FOV: 50 degrees; color fundus image; pupil-dilated.
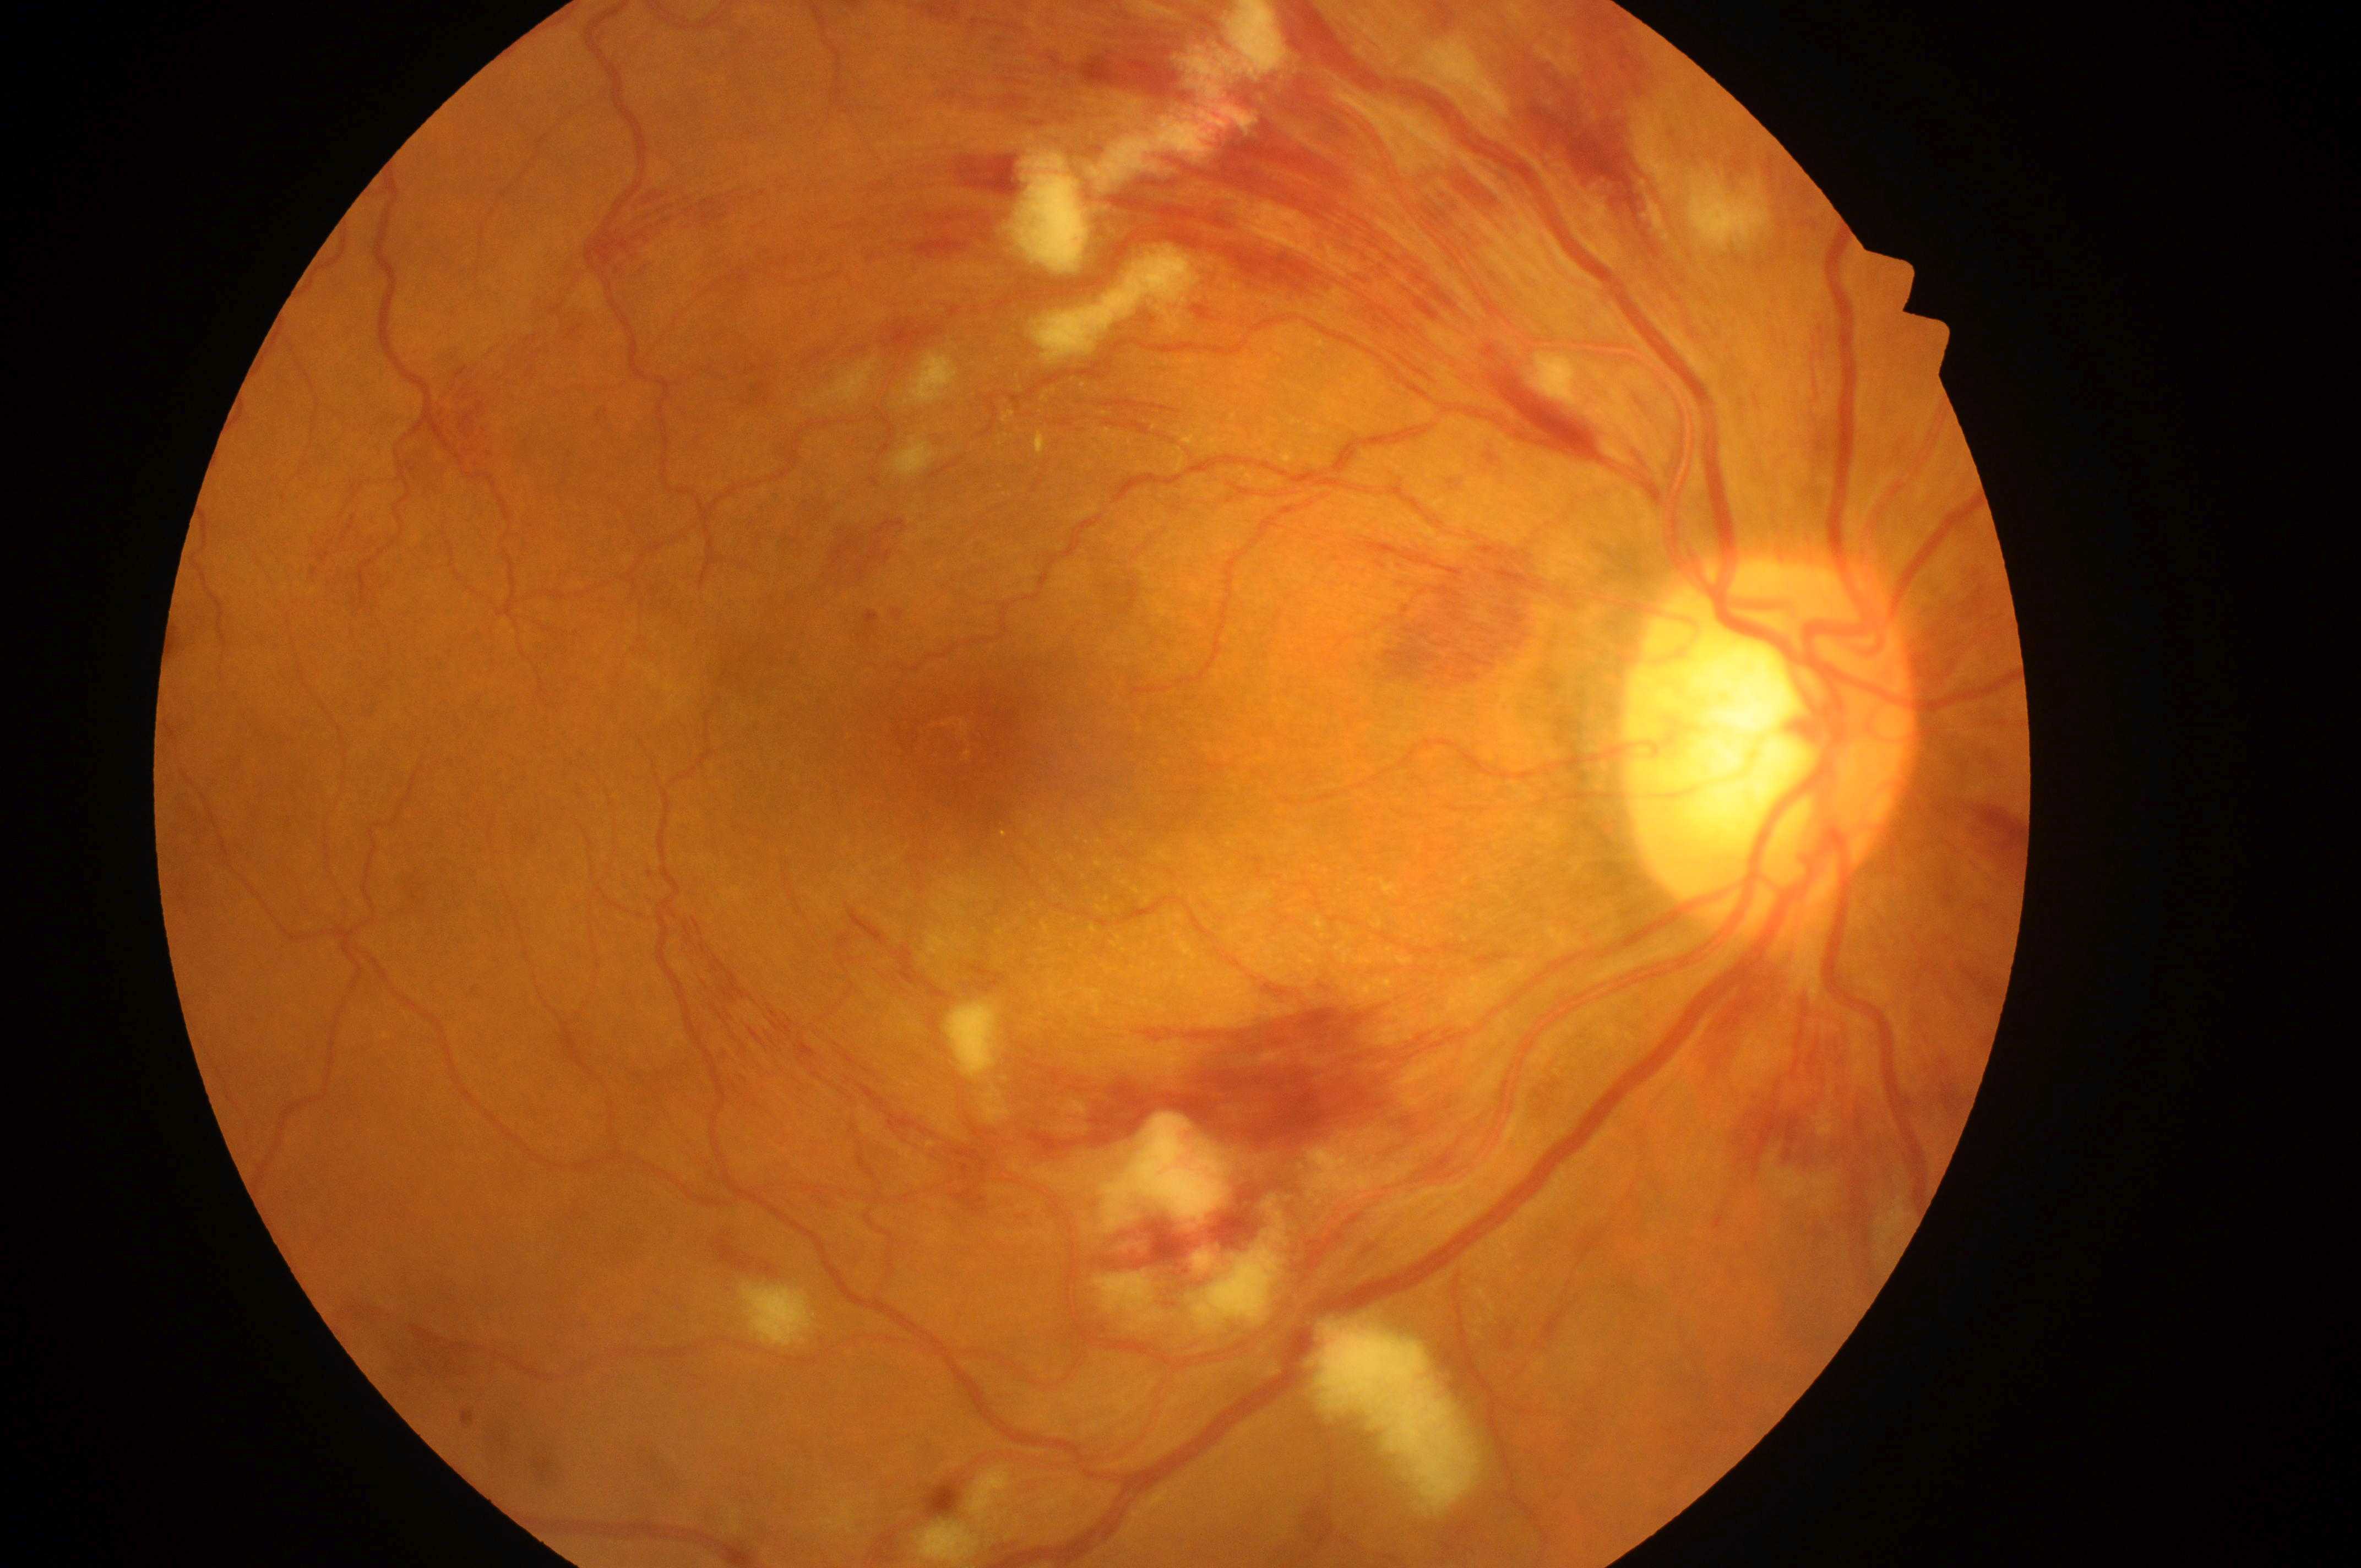

- macula center · (959,740)
- ONH · (1761,748)
- DR severity · severe non-proliferative diabetic retinopathy (grade 3) — more than 20 intraretinal hemorrhages in each of 4 quadrants, definite venous beading in 2 or more quadrants, or prominent intraretinal microvascular abnormalities in 1 or more quadrants, with no signs of proliferative retinopathy
- DME · grade 2 (high risk) — hard exudates within one disc diameter of the macula center
- laterality · right eye